Infant wide-field retinal image
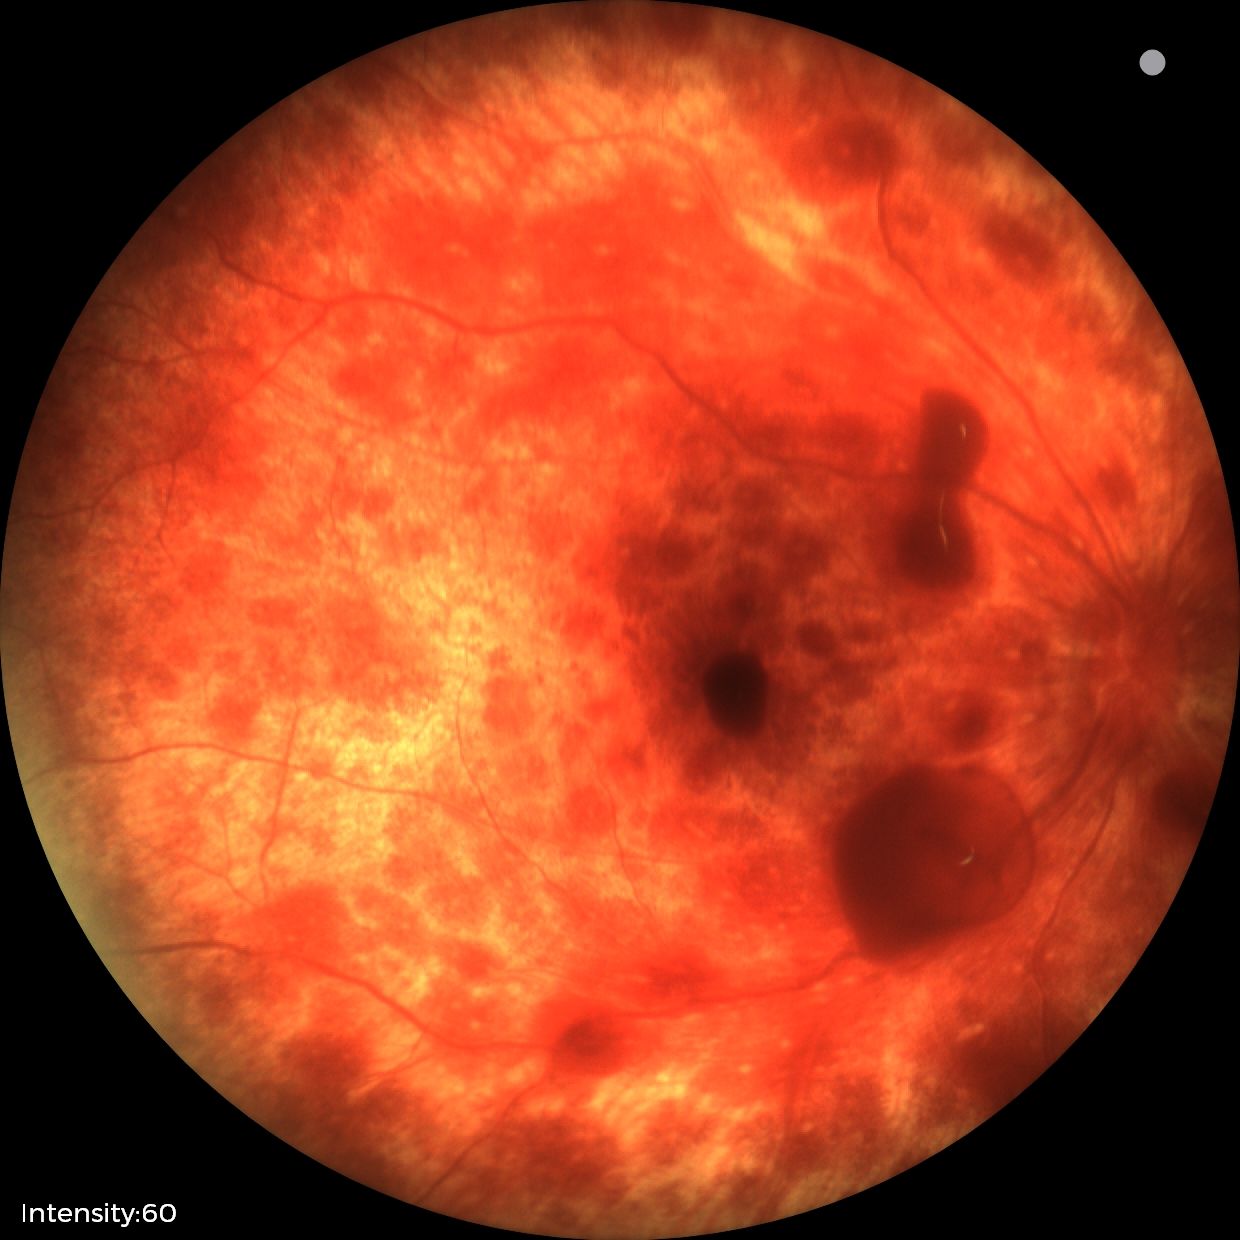

Series diagnosed as retinal hemorrhages.